Wide-field contact fundus photograph of an infant — 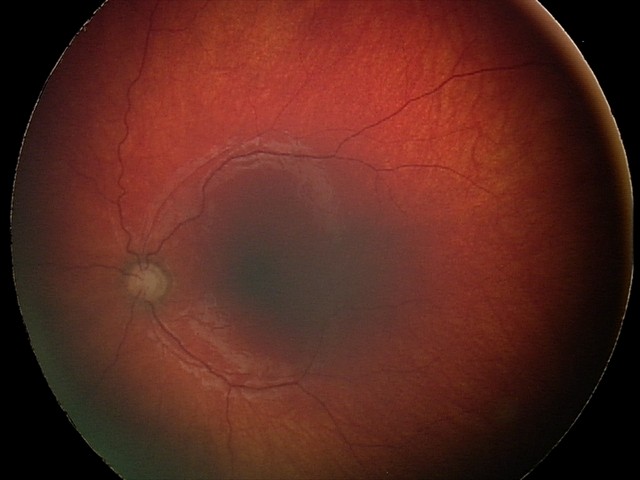
Series diagnosed as optic nerve hypoplasia.